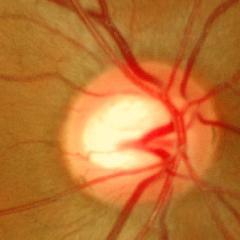

Glaucoma diagnosis: no signs of glaucoma.